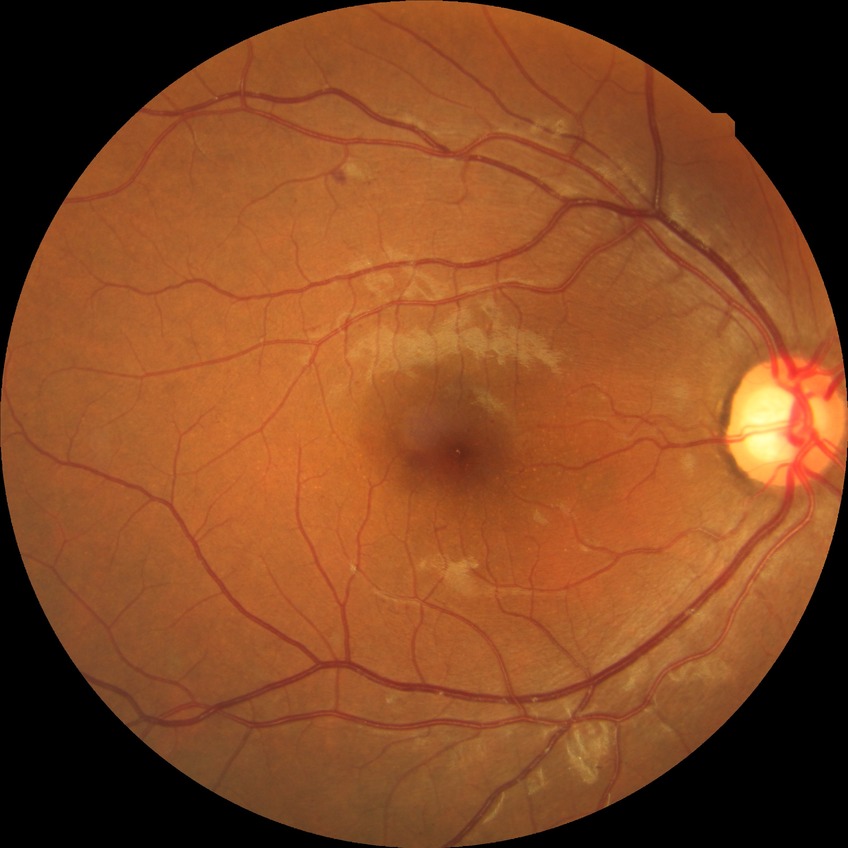

Davis DR grade = PPDR.